CFP
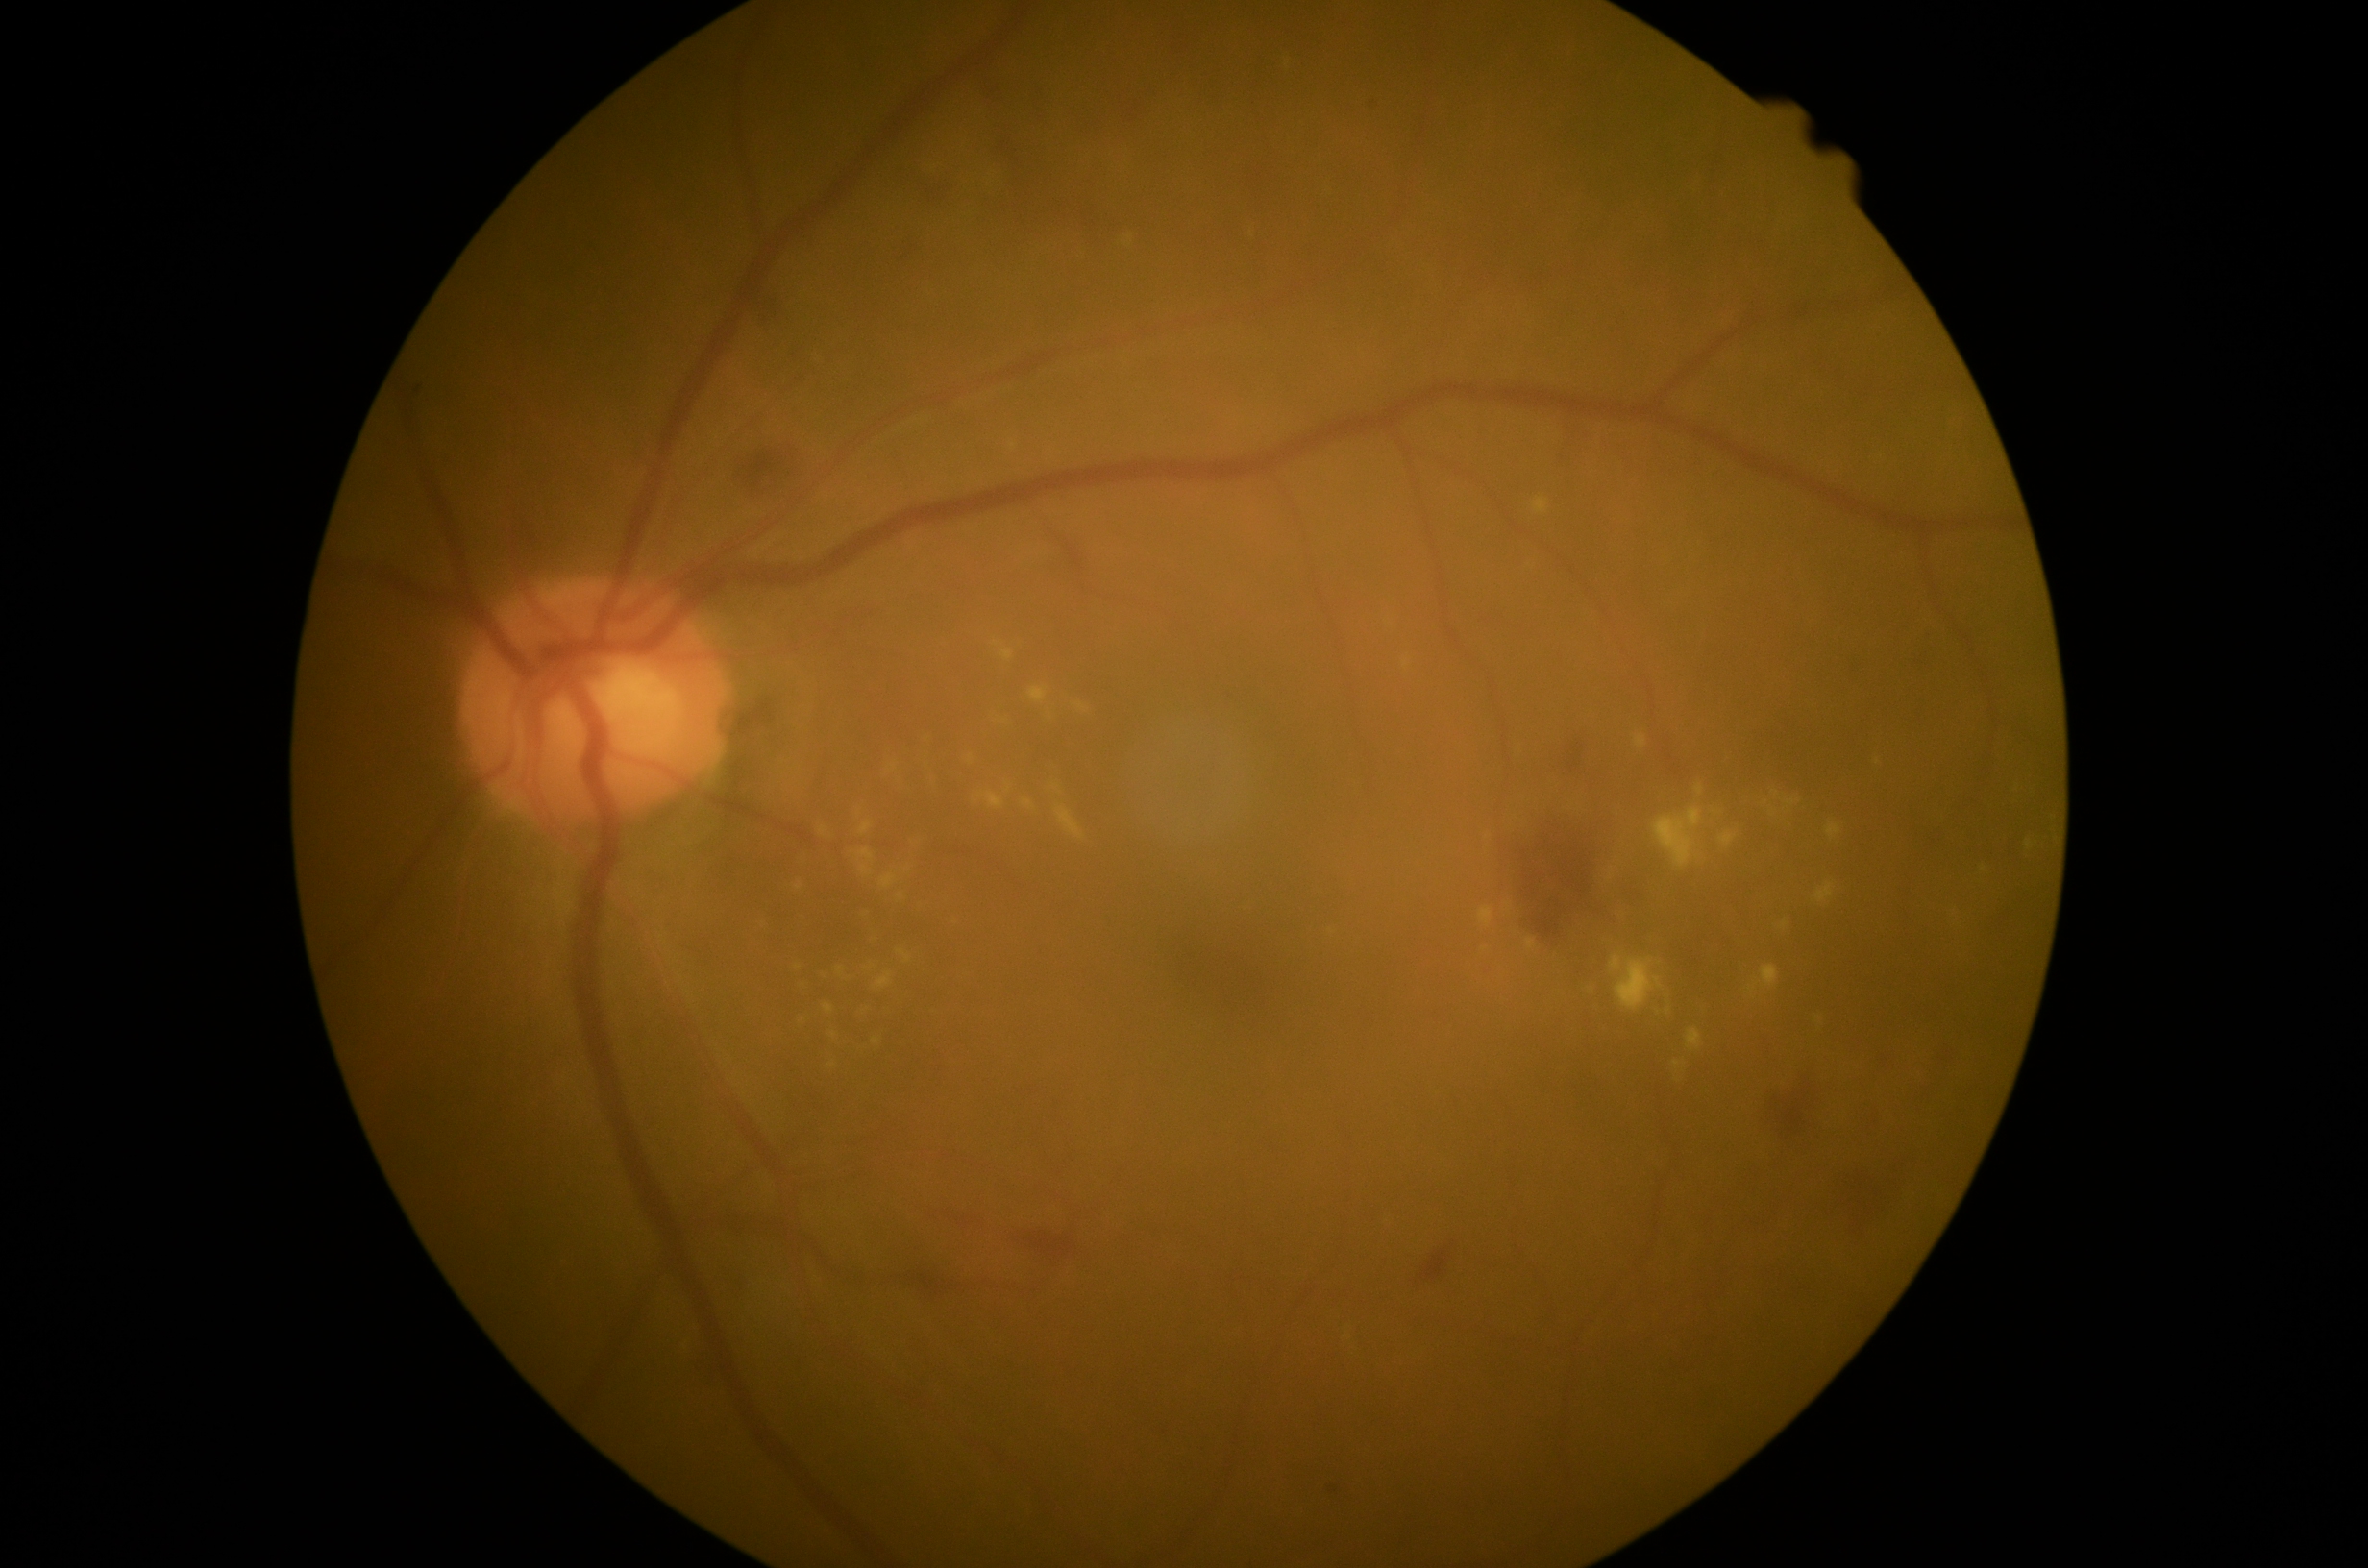

DR grade: 2 — more than just microaneurysms but less than severe NPDR; non-proliferative diabetic retinopathy
A subset of detected lesions:
EXs (continued): (x1=974, y1=793, x2=1005, y2=811), (x1=1526, y1=939, x2=1537, y2=951), (x1=1827, y1=822, x2=1842, y2=840), (x1=1787, y1=800, x2=1801, y2=807), (x1=875, y1=972, x2=894, y2=991), (x1=1001, y1=649, x2=1014, y2=663), (x1=1696, y1=786, x2=1704, y2=796), (x1=829, y1=1064, x2=837, y2=1069), (x1=866, y1=965, x2=875, y2=972), (x1=1612, y1=956, x2=1664, y2=1012), (x1=1719, y1=831, x2=1739, y2=848)
Small EXs near <point>1660, 964</point>, <point>901, 897</point>, <point>972, 758</point>, <point>1669, 1012</point>, <point>1984, 870</point>
HEs (continued): (x1=1563, y1=423, x2=1589, y2=486), (x1=1081, y1=207, x2=1102, y2=231), (x1=1633, y1=893, x2=1642, y2=902), (x1=1016, y1=180, x2=1026, y2=187), (x1=1840, y1=1173, x2=1887, y2=1231), (x1=999, y1=138, x2=1021, y2=166), (x1=1896, y1=1063, x2=1936, y2=1175), (x1=900, y1=246, x2=920, y2=263), (x1=753, y1=297, x2=777, y2=328), (x1=734, y1=448, x2=799, y2=500)
Small HEs near <point>1021, 221</point>, <point>1017, 171</point>, <point>1005, 209</point>